848x848; 45° FOV; nonmydriatic fundus photograph
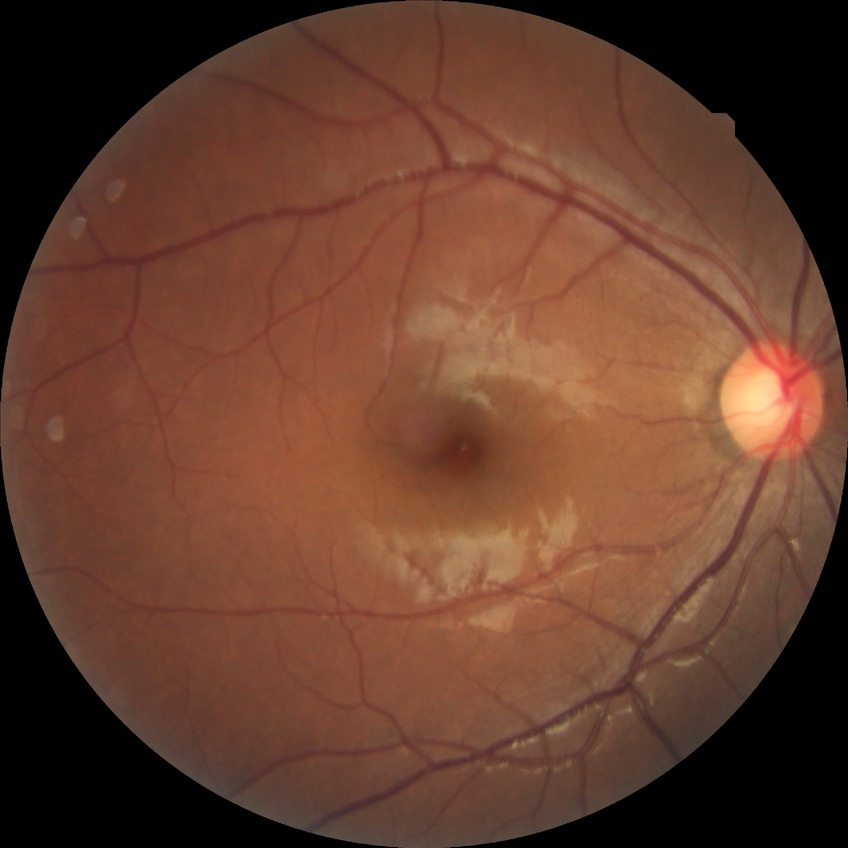
Diabetic retinopathy (DR): NDR (no diabetic retinopathy).